Nidek AFC-330. 240 by 240 pixels. Optic disc-centered crop: 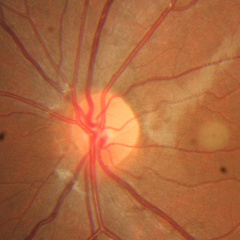 Diagnosis = no glaucoma.